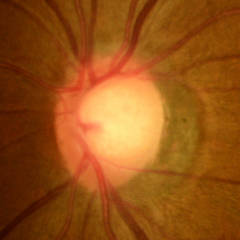

Demonstrates no glaucomatous changes.